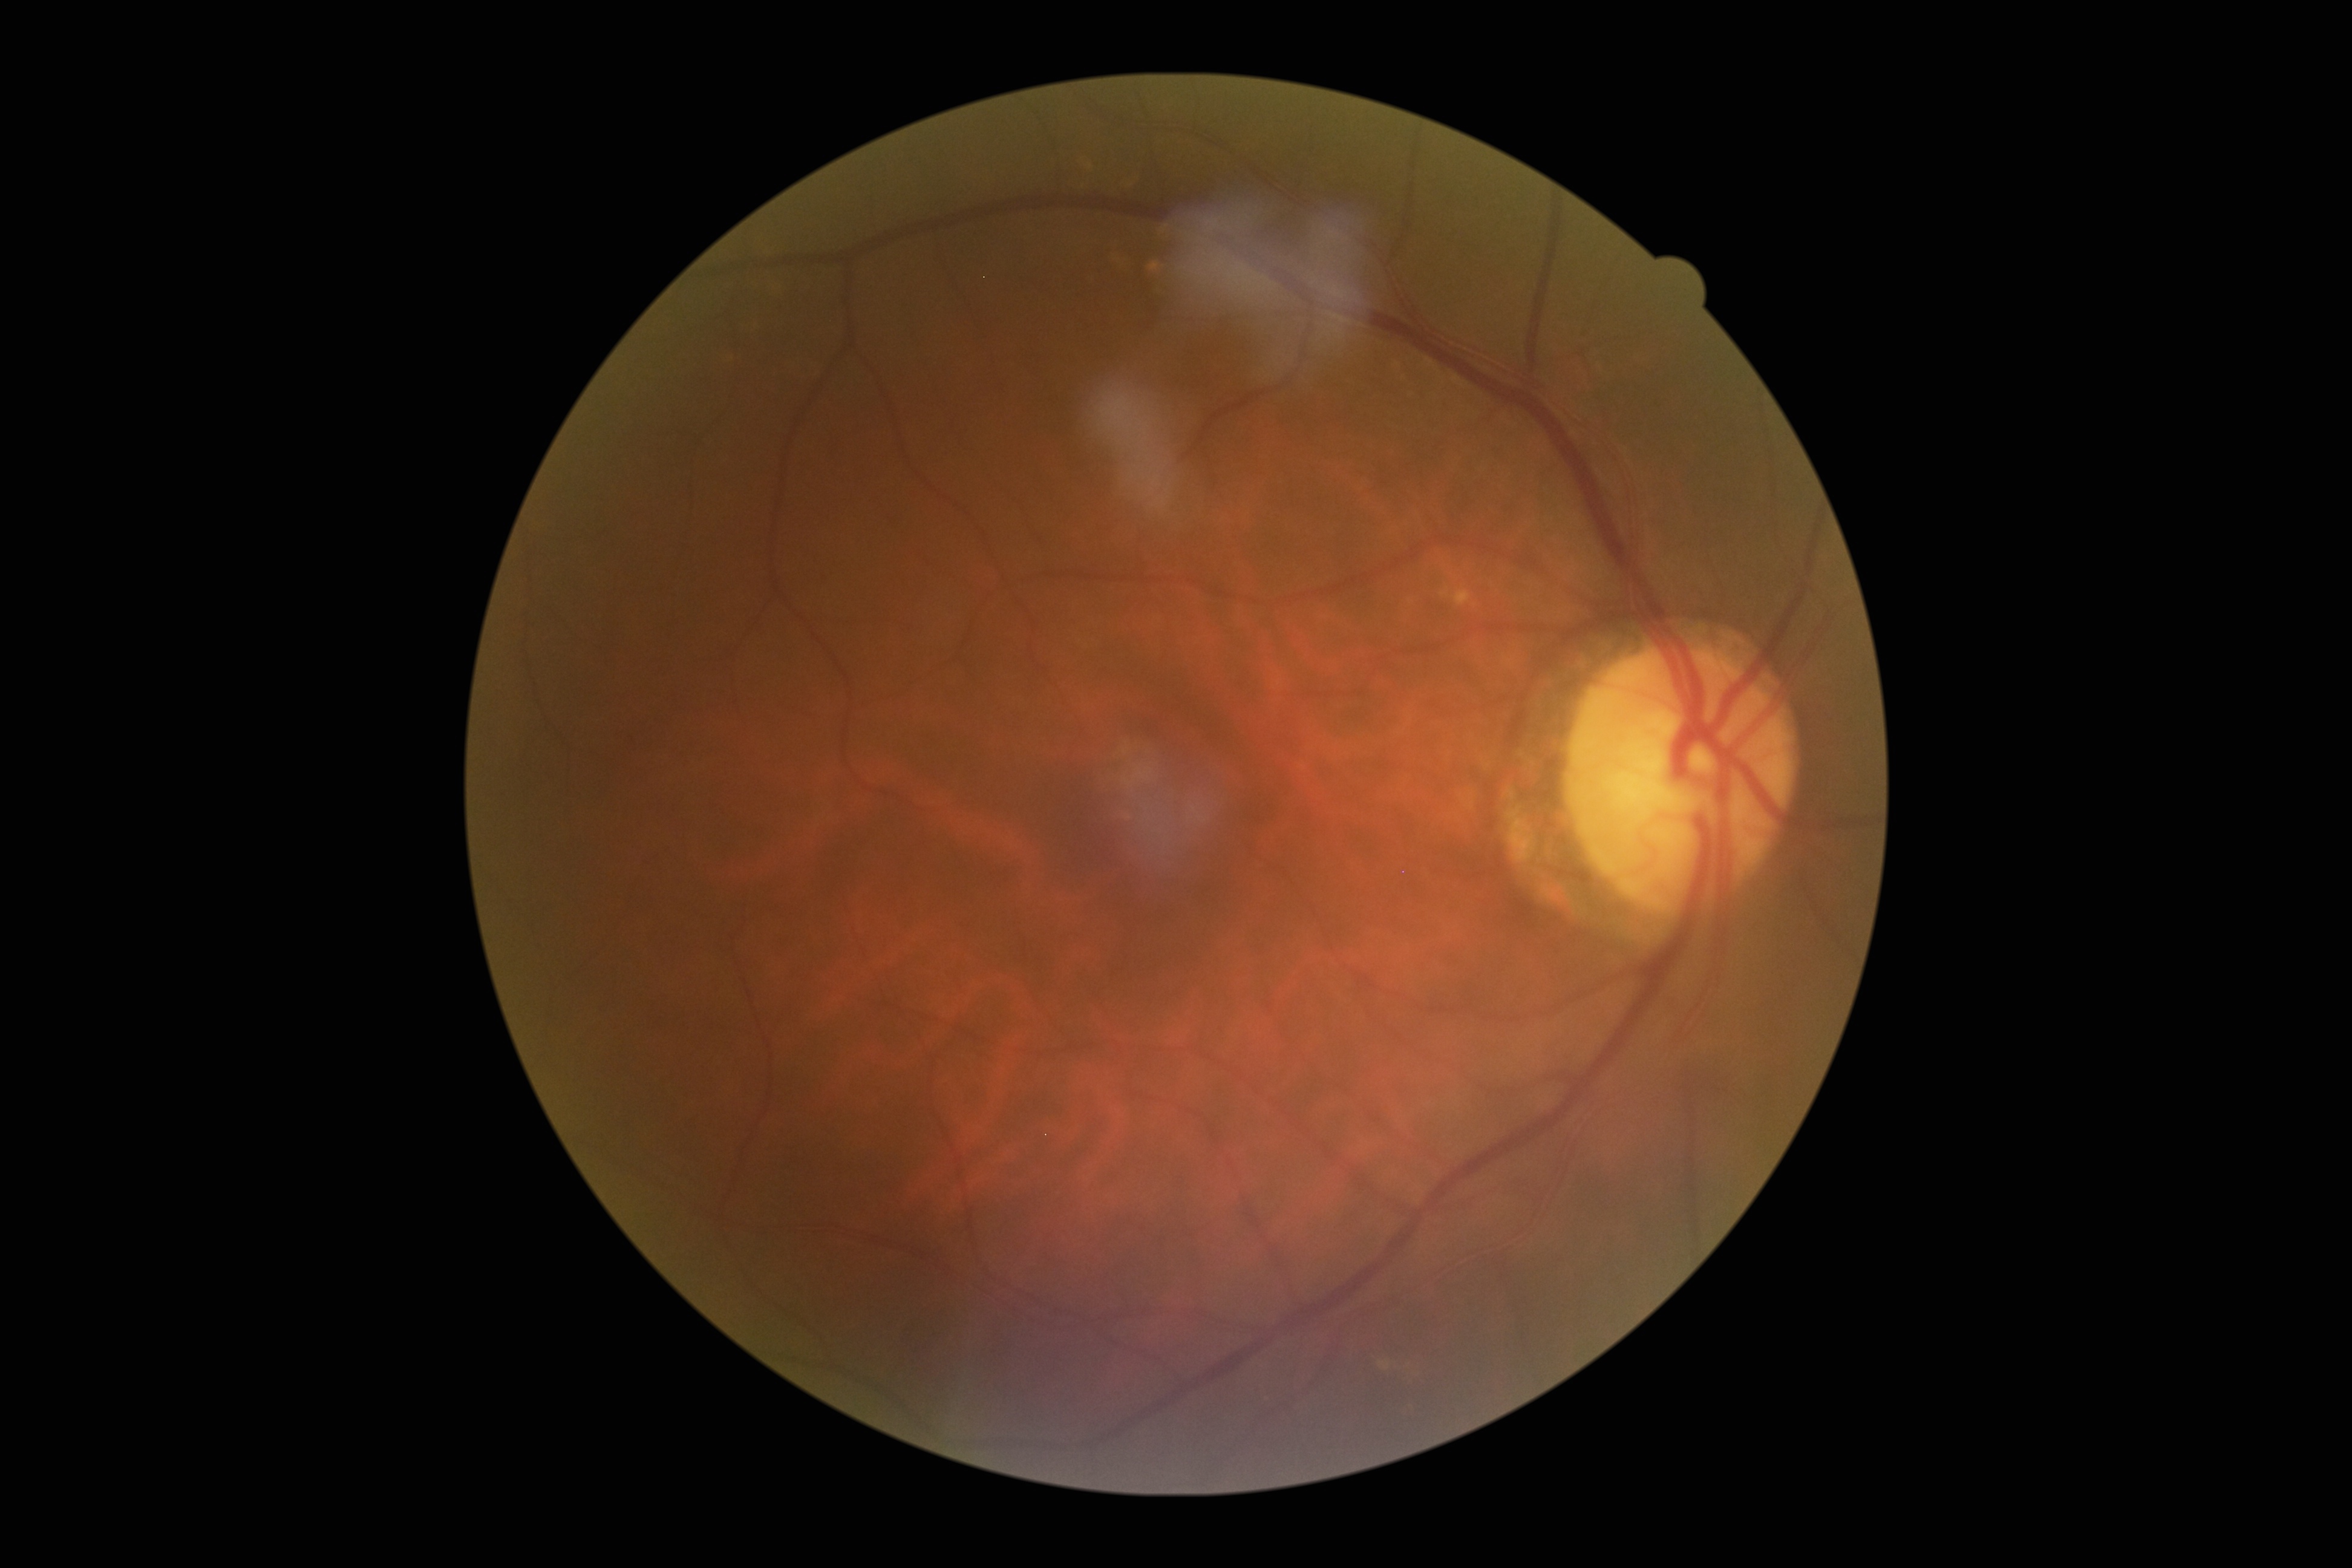
dr_grade: 0
dr_impression: no apparent DR